Retinal fundus photograph · 1534 x 1534 pixels — 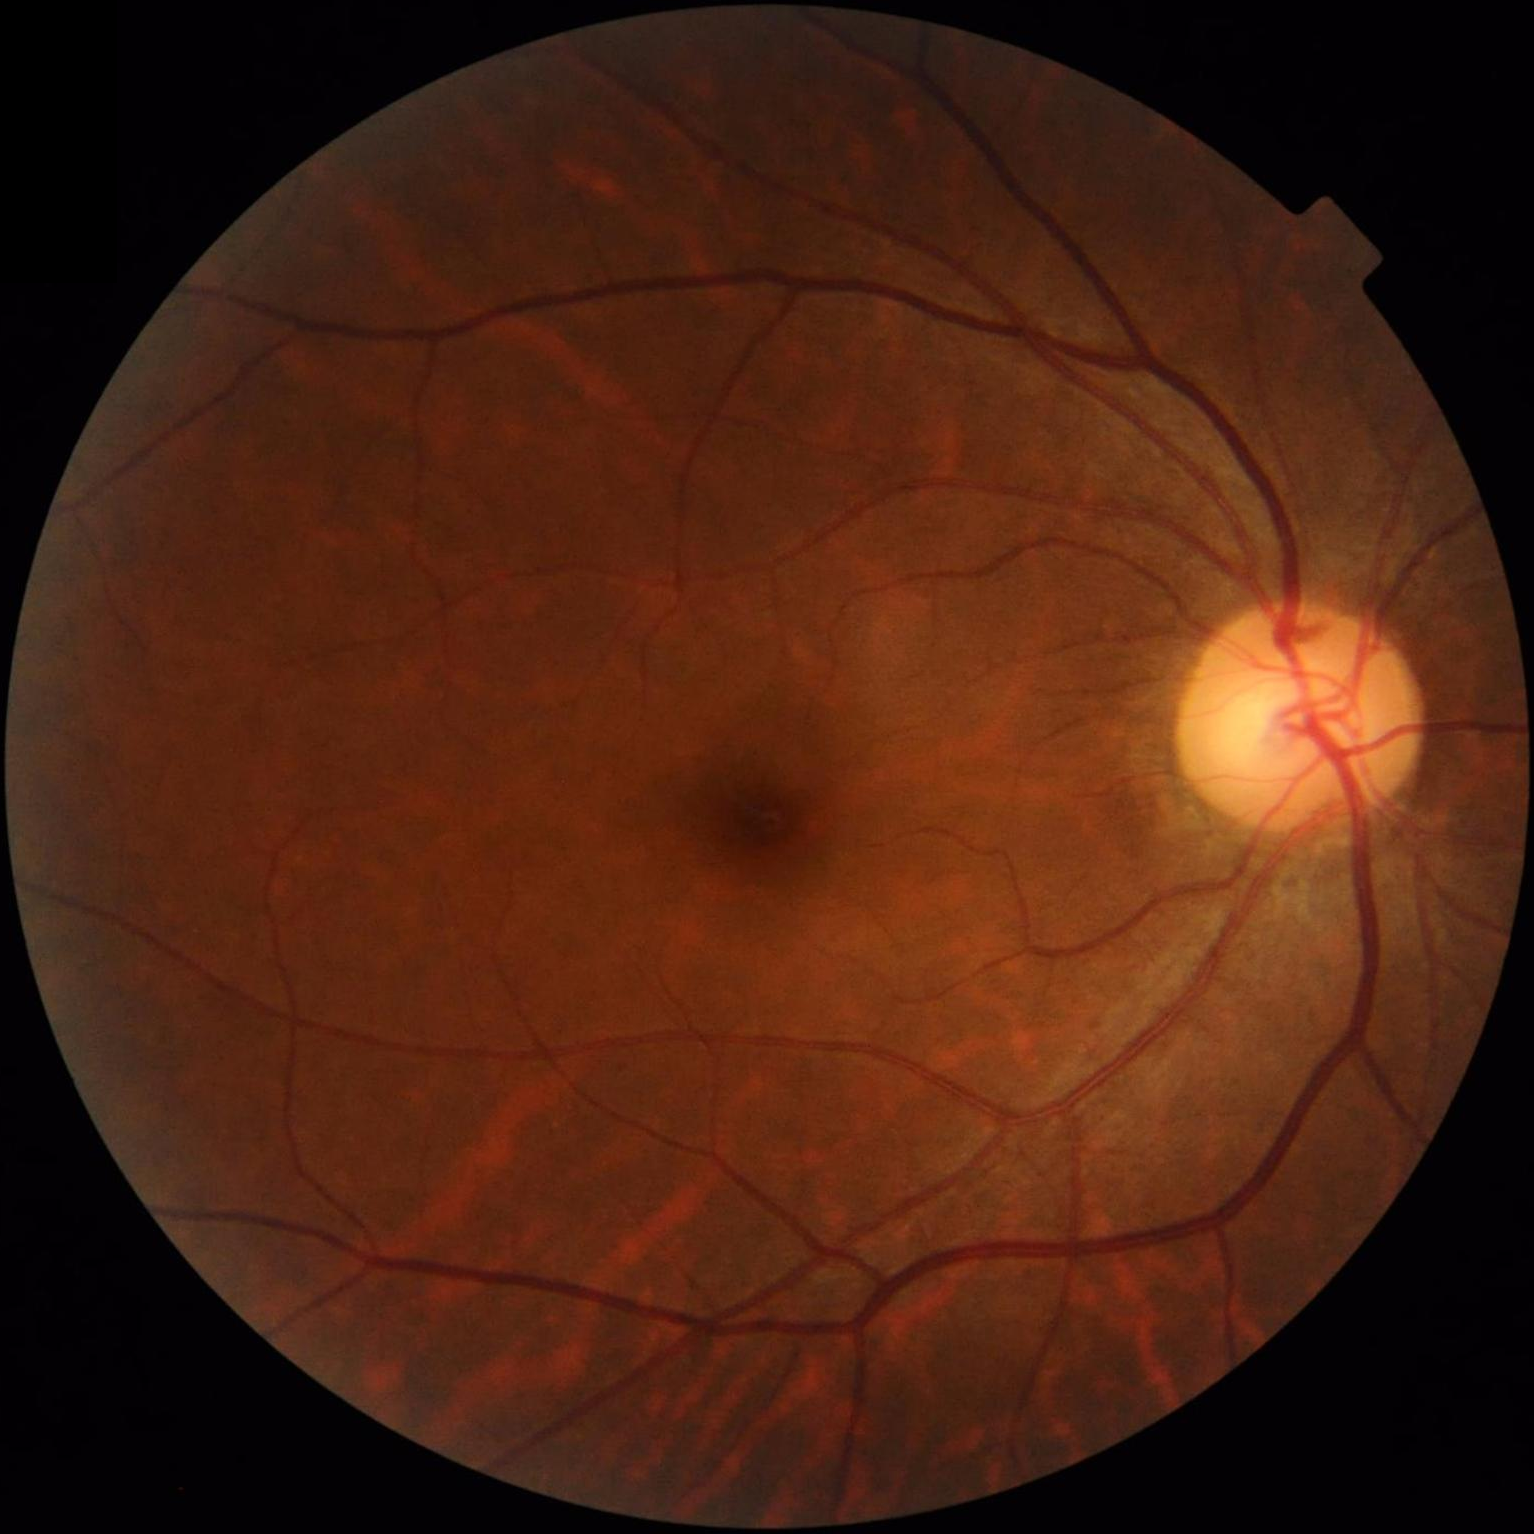 Overall quality = adequate
Contrast = satisfactory
Clarity = good
Illumination = satisfactory